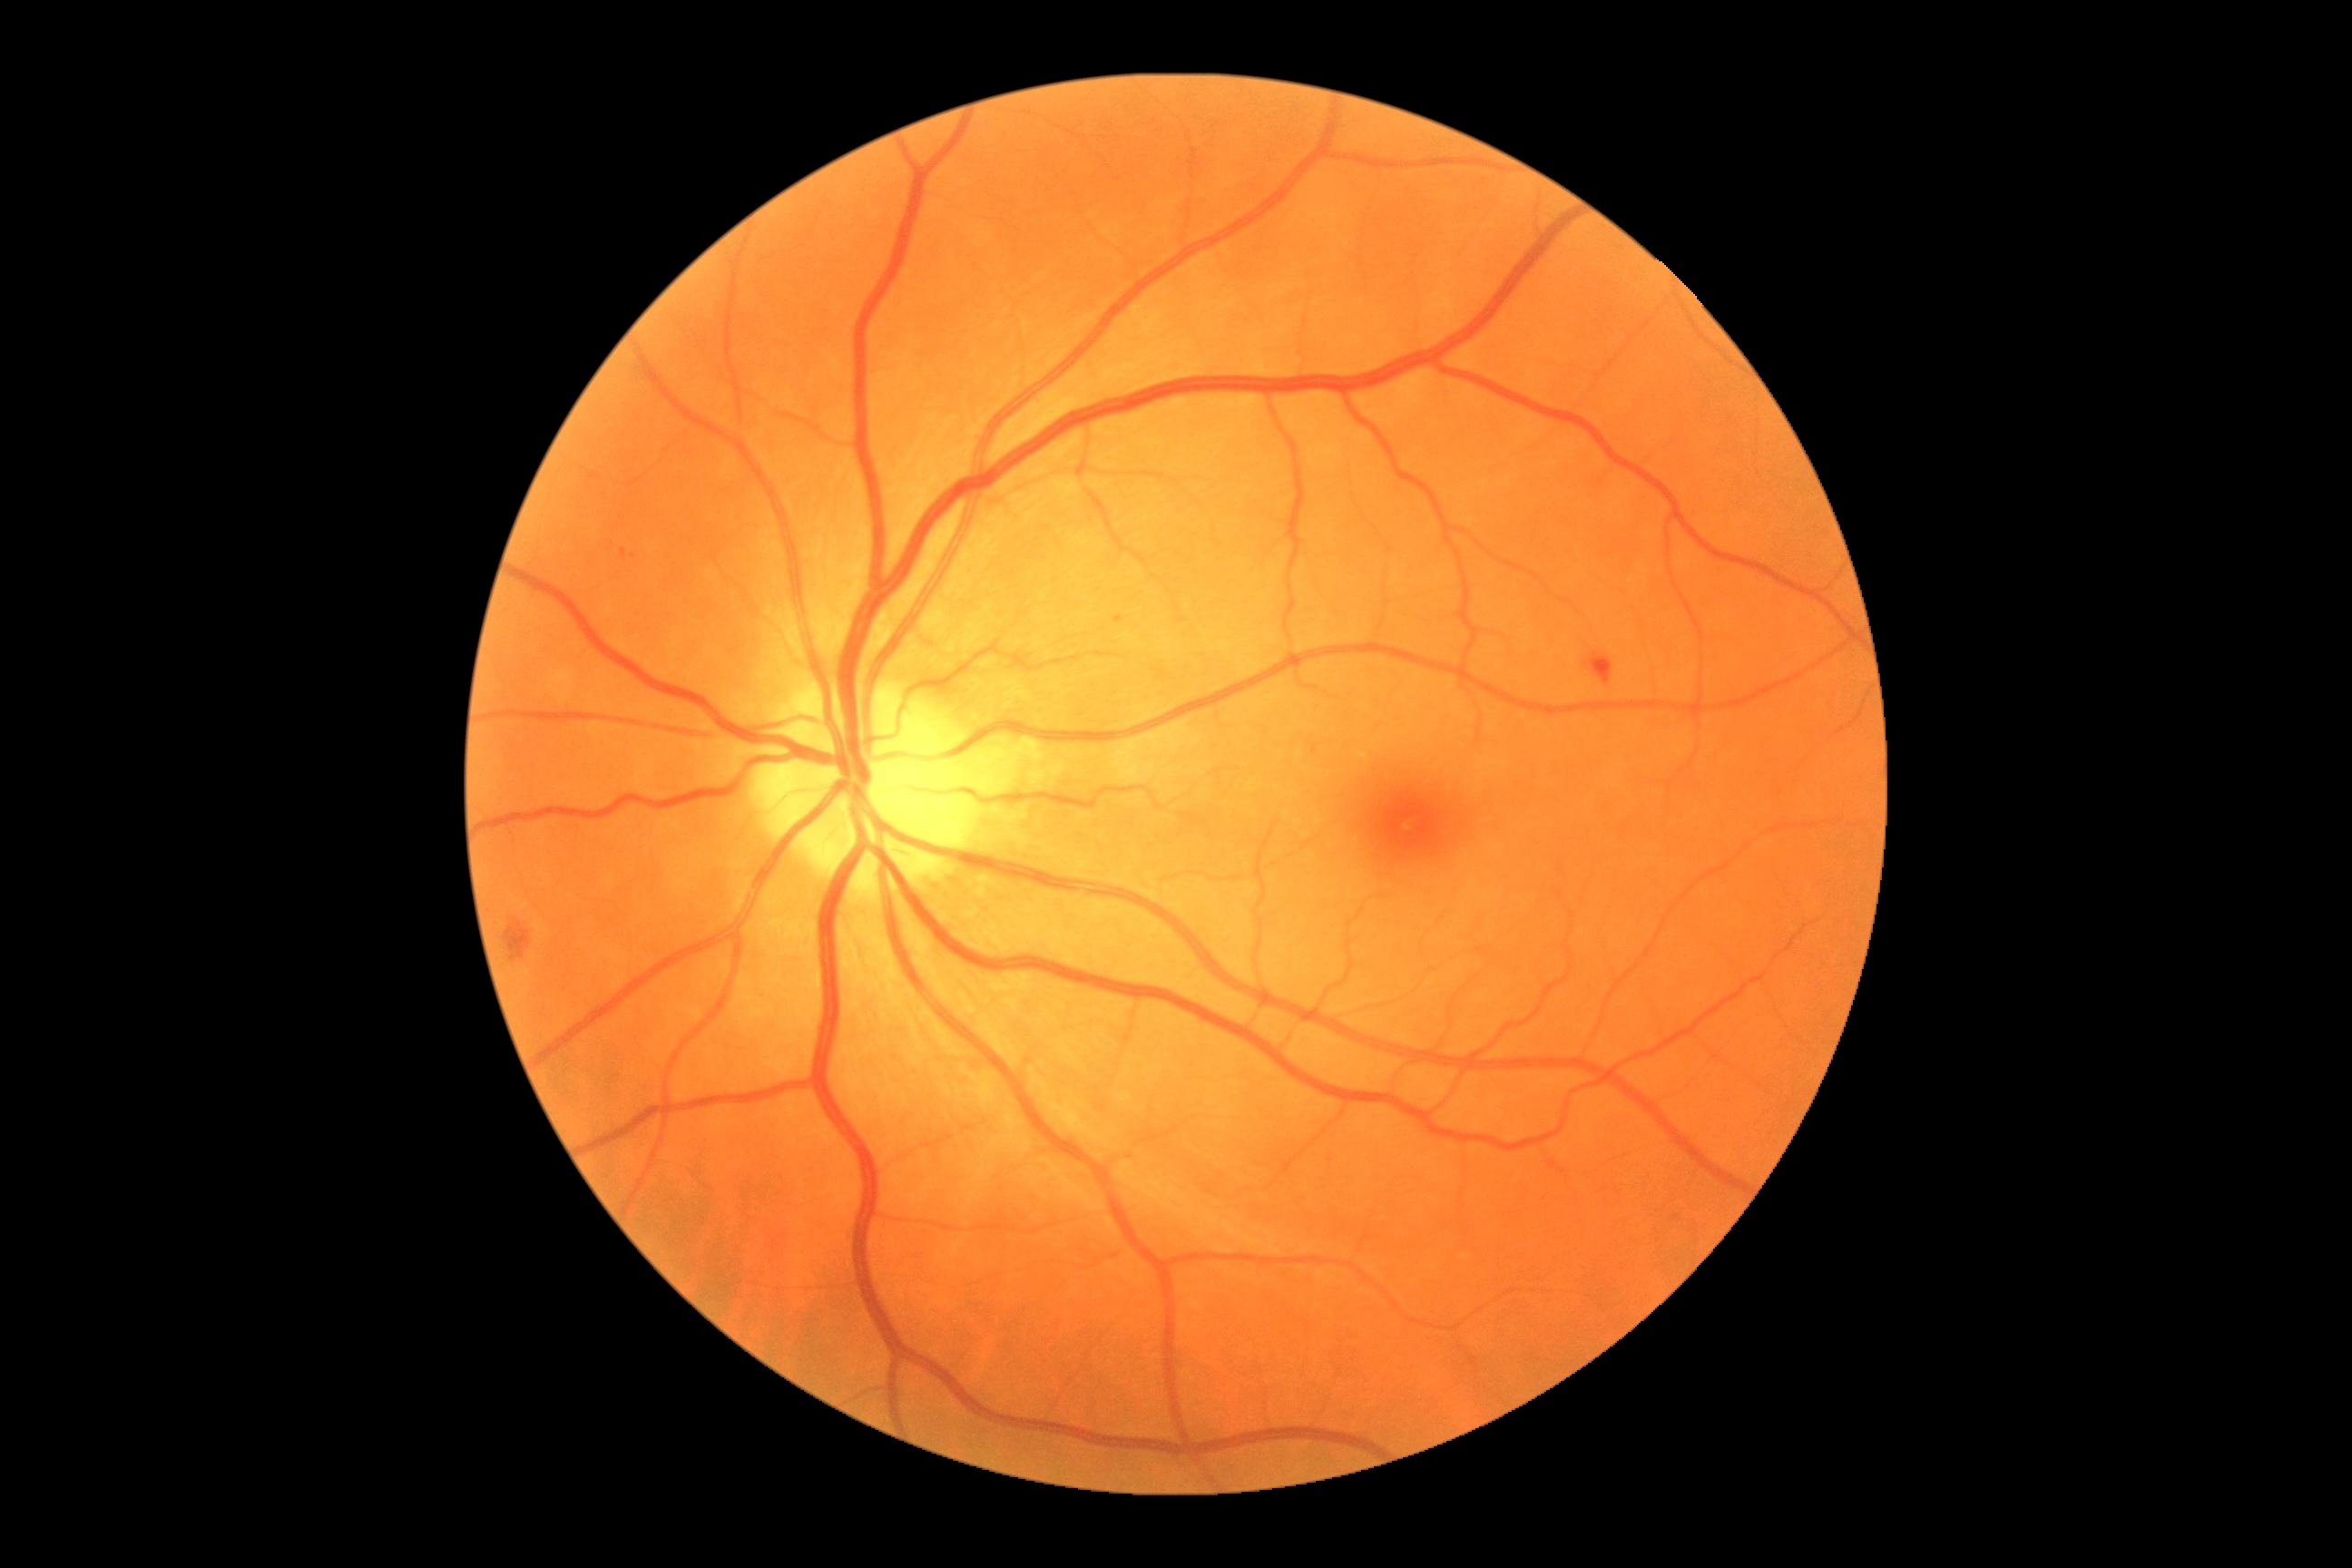 partial: true
dr_grade: 2
dr_grade_name: moderate NPDR
lesions:
  ex: []
  ma: []
  he:
    - 622,549,627,560
    - 505,919,531,961
    - 1591,654,1612,685
  he_small:
    - [1121,619]
  se: []